1240x1240. Phoenix ICON wide-field infant fundus image.
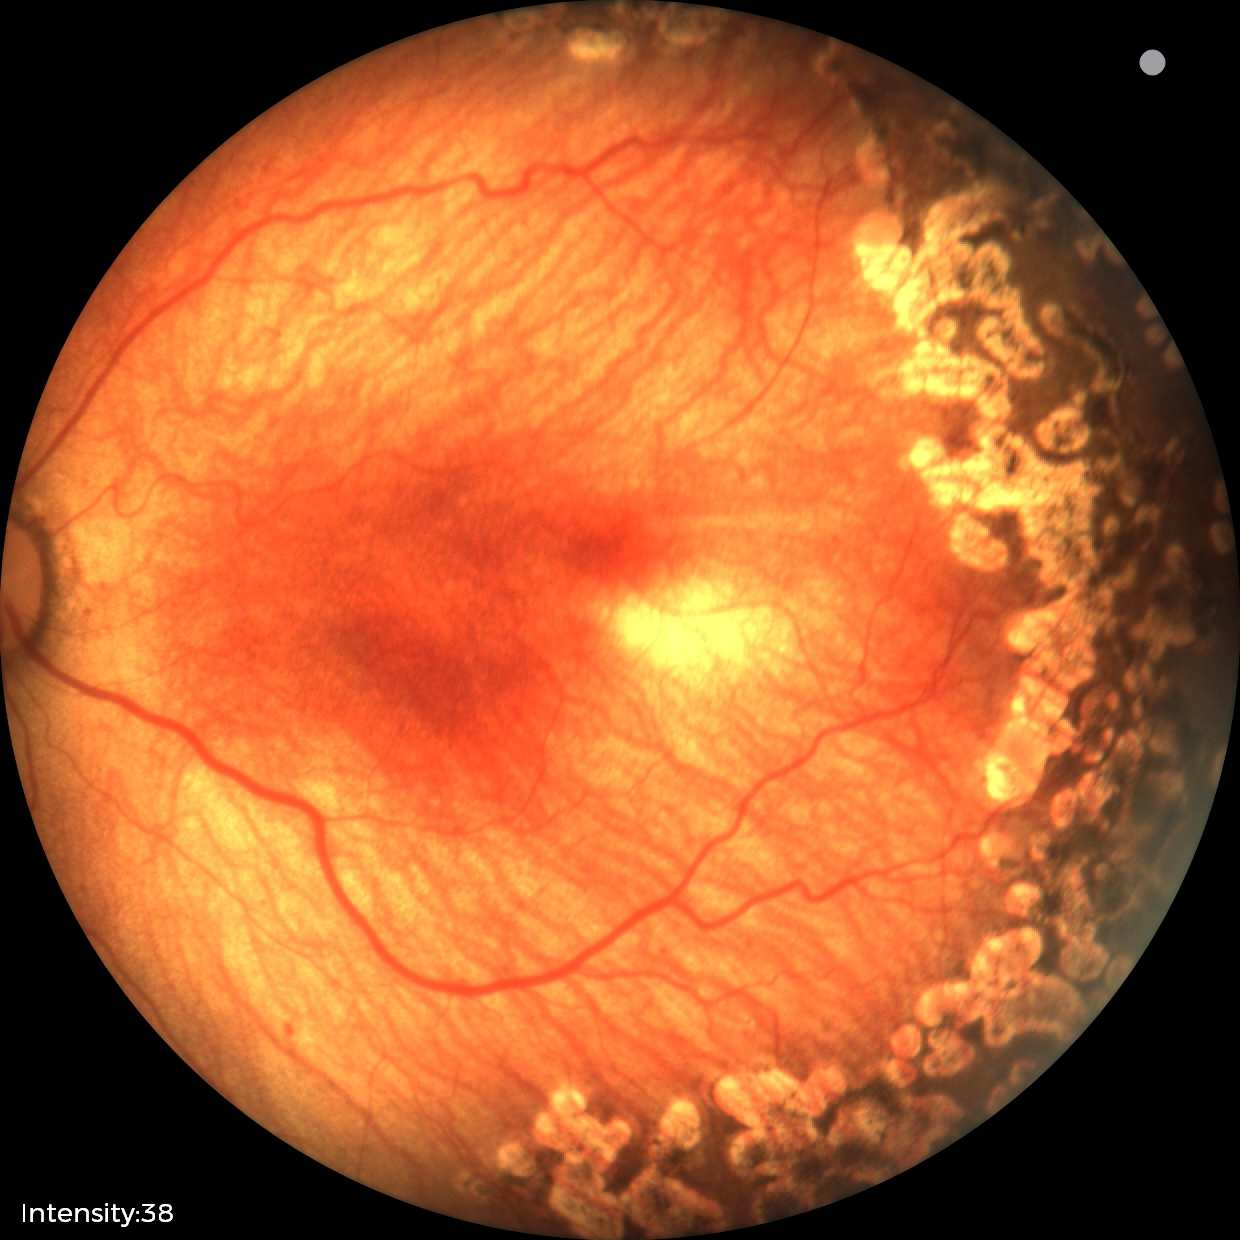 No plus disease.
Examination diagnosed as status post ROP.